45° field of view:
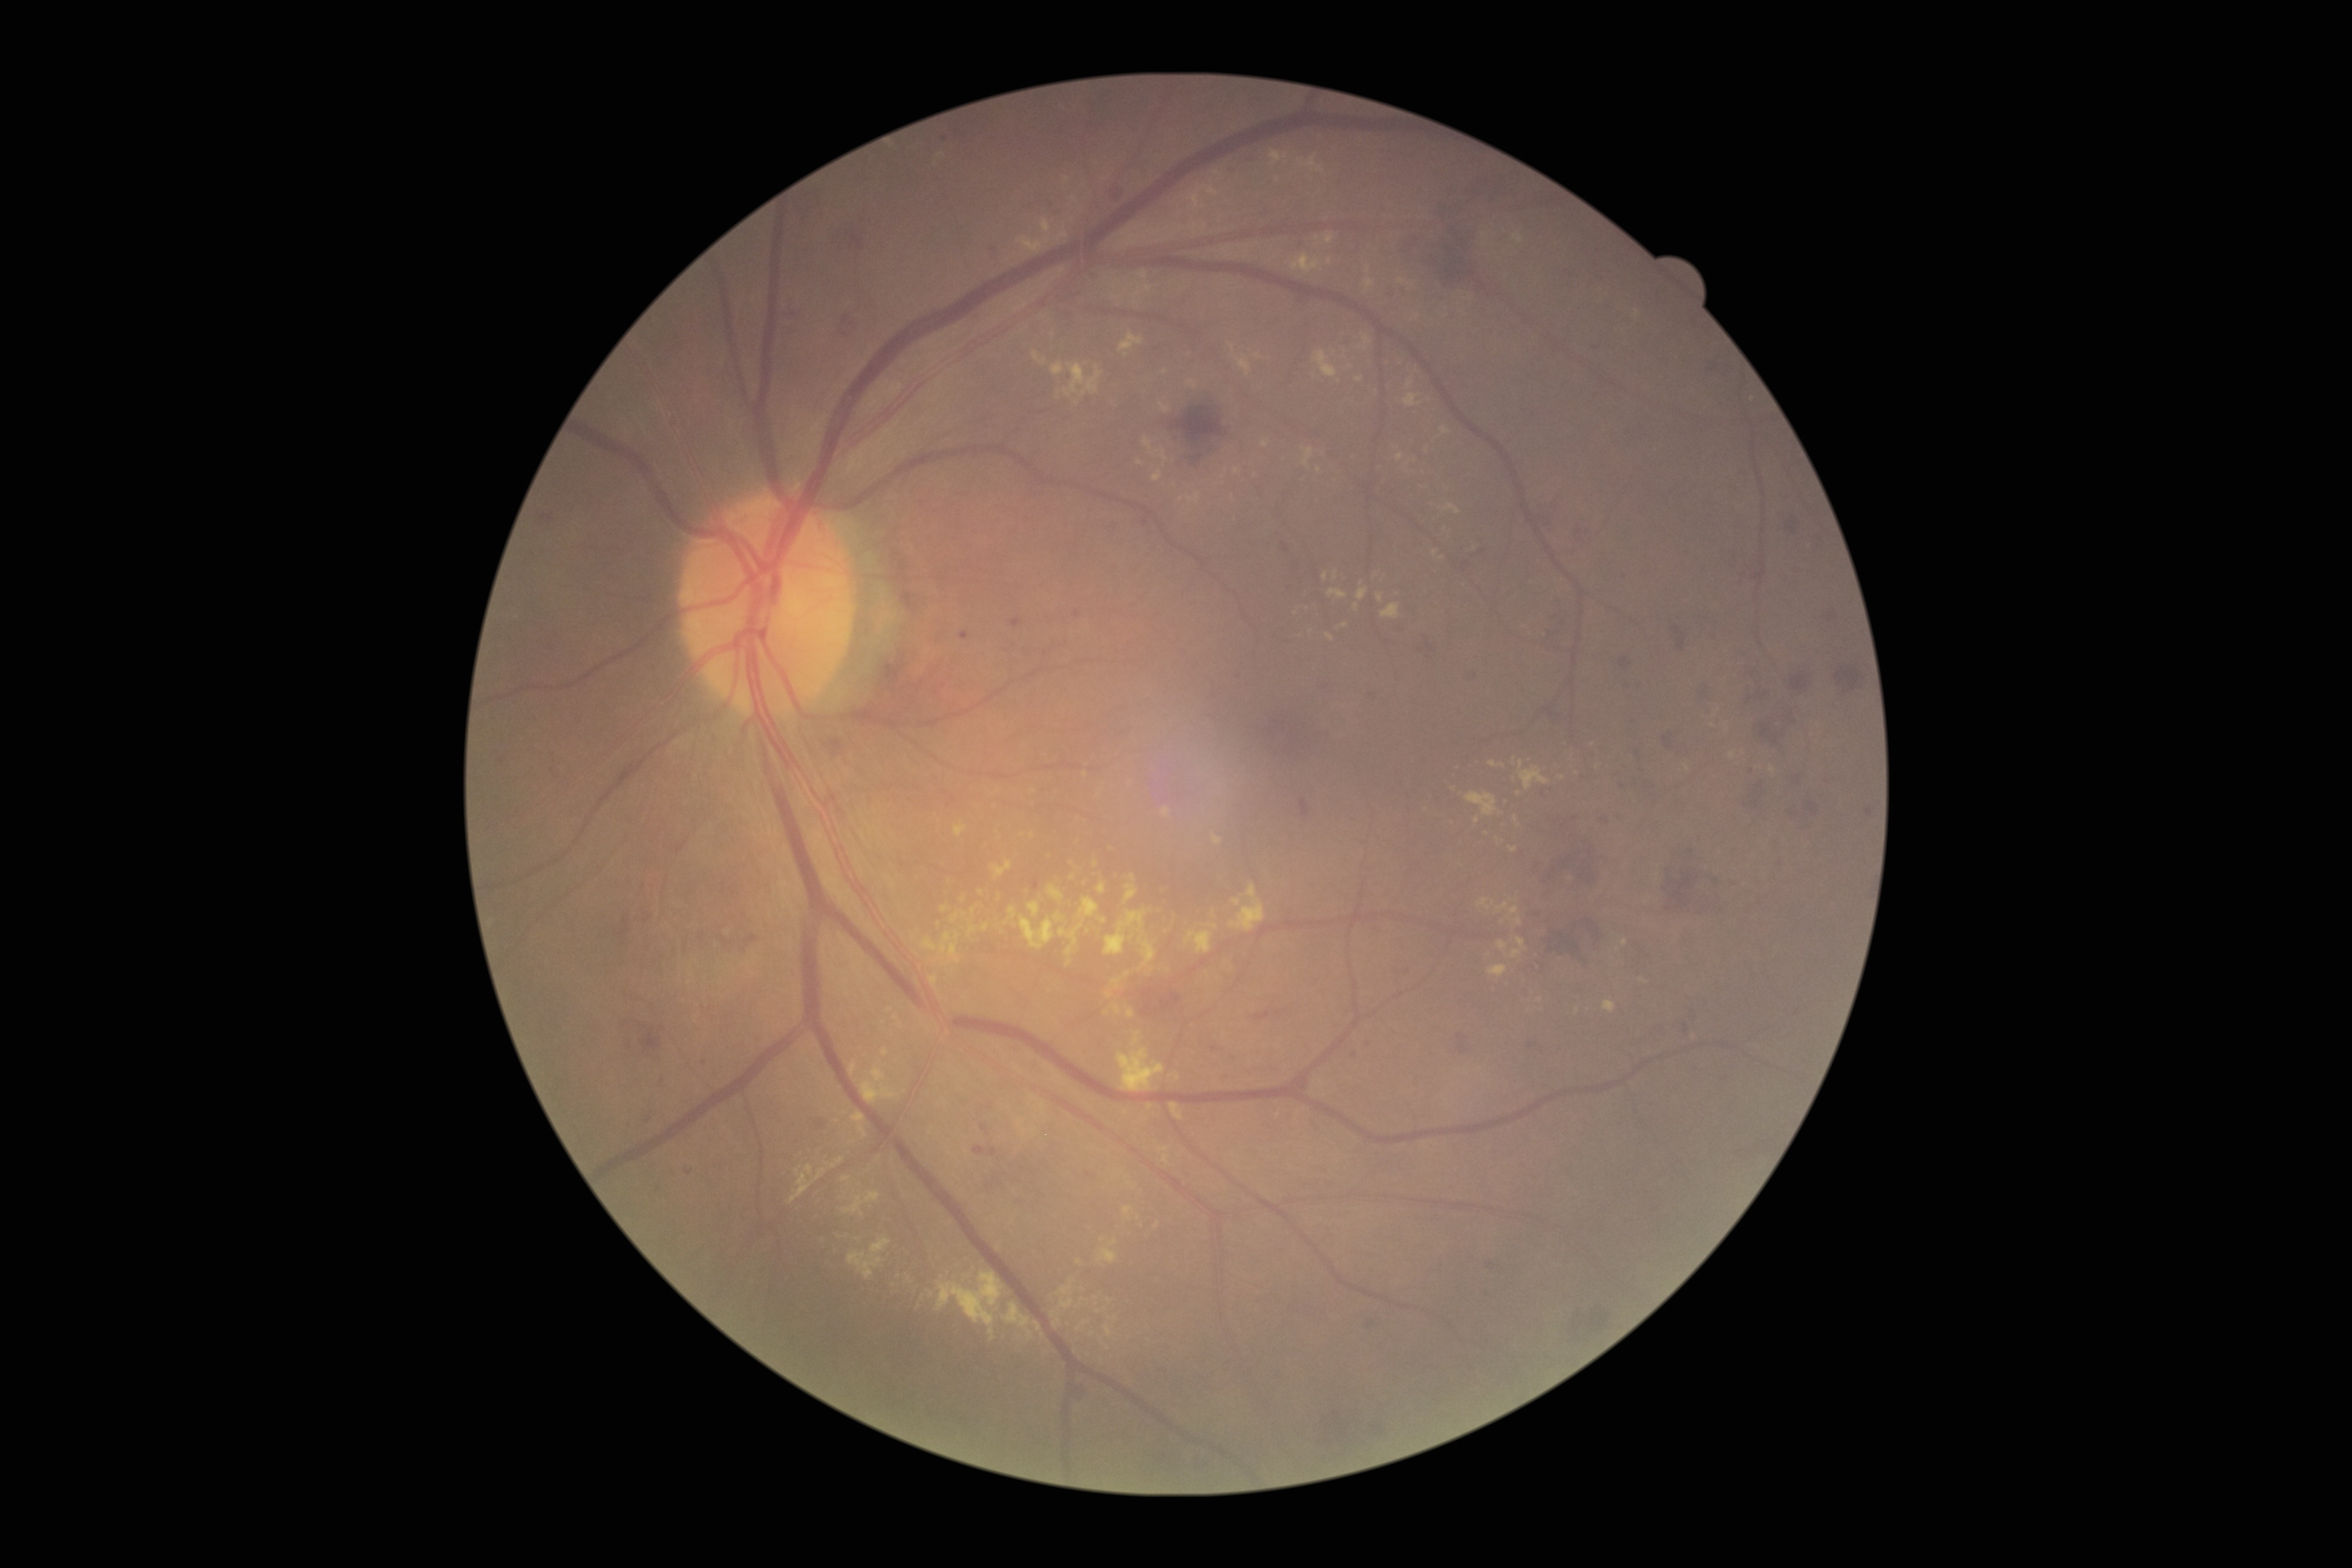 {"partial":true,"dr_grade":2,"dr_grade_name":"moderate NPDR","lesions":{"he":[[1618,682,1630,687],[1547,631,1560,643],[1745,696,1755,710],[1331,1410,1348,1437],[1806,802,1817,821],[1550,708,1561,720],[989,1148,998,1156],[1749,706,1795,748],[1069,1382,1086,1396],[1281,543,1289,554],[1459,1044,1468,1054],[1791,675,1808,691],[1459,557,1471,572],[1544,835,1602,895],[639,1024,661,1052],[1359,1319,1375,1329],[1110,183,1125,201]],"ex":[[1381,603,1400,619],[1327,258,1331,266],[1714,710,1720,718],[1105,909,1156,971],[1138,272,1148,280],[1363,335,1373,350],[1077,1321,1088,1331],[930,975,937,988],[1356,377,1364,382],[1033,351,1046,366],[1018,235,1052,252],[1233,898,1241,907],[1059,923,1083,955]],"ex_small_centers":[[1336,576],[1217,174],[1223,477],[1469,767],[1033,835],[1157,1226]]}}